45-degree field of view.
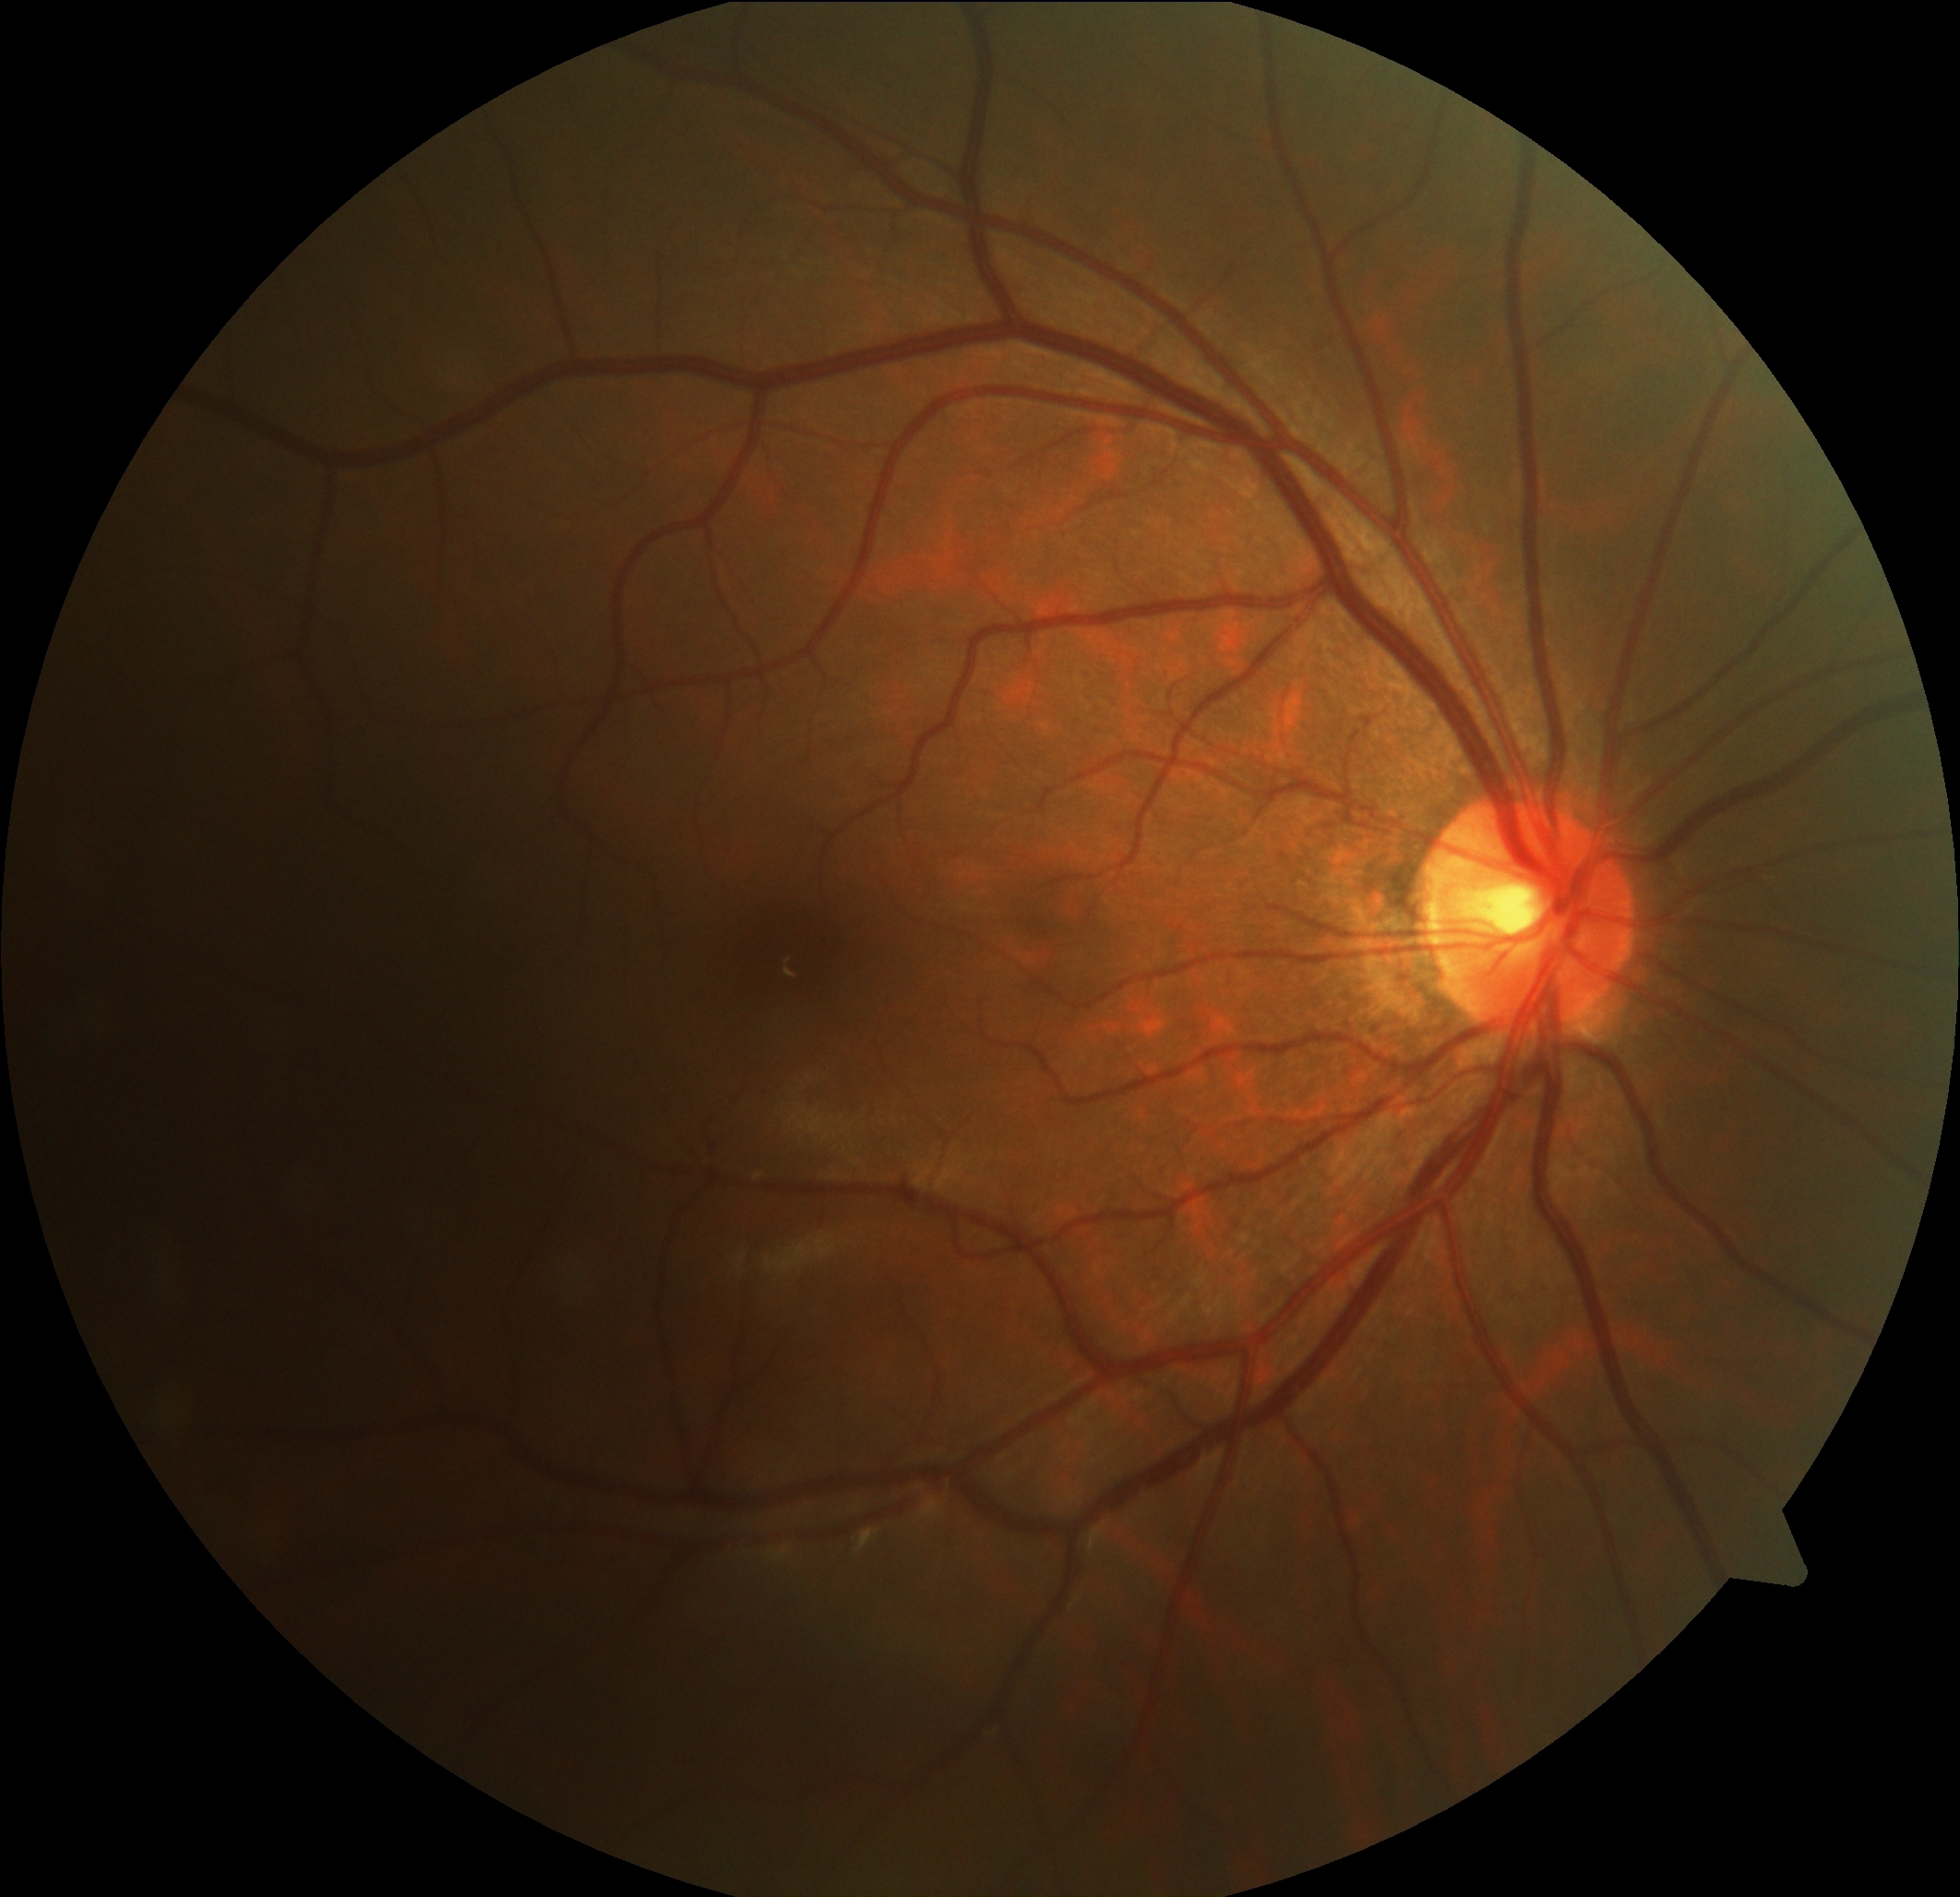

No apparent diabetic retinopathy. Diabetic retinopathy (DR) is grade 0 (no apparent retinopathy) — no visible signs of diabetic retinopathy.